No pharmacologic dilation, DR severity per modified Davis staging, 45° field of view, posterior pole photograph.
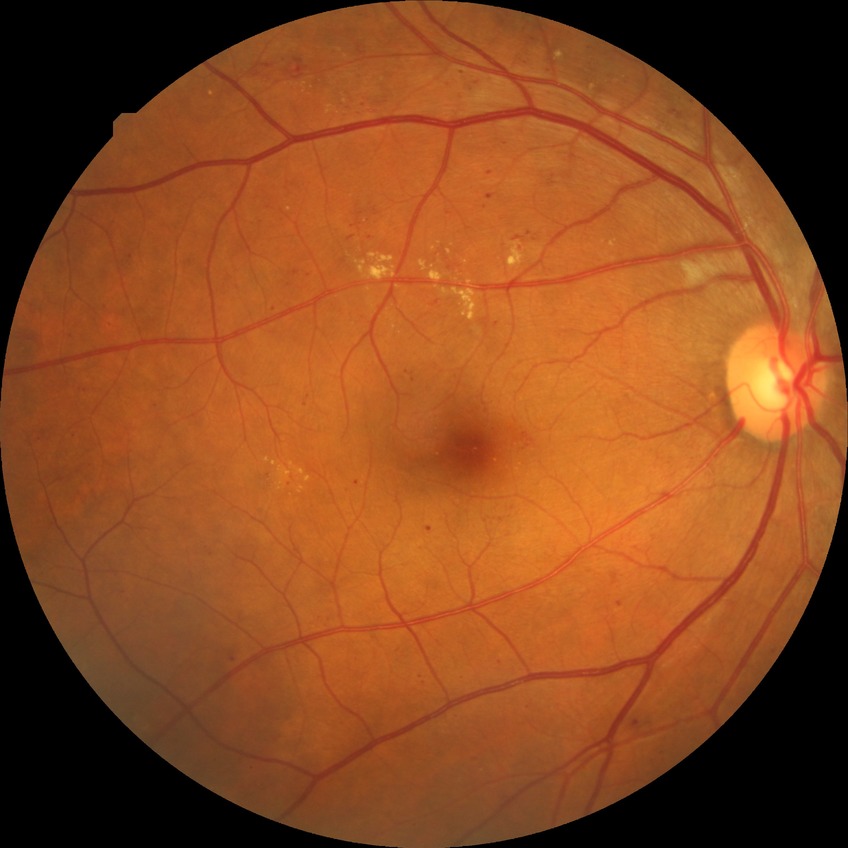 Diabetic retinopathy (DR): SDR (simple diabetic retinopathy).